1470 x 1137 pixels: 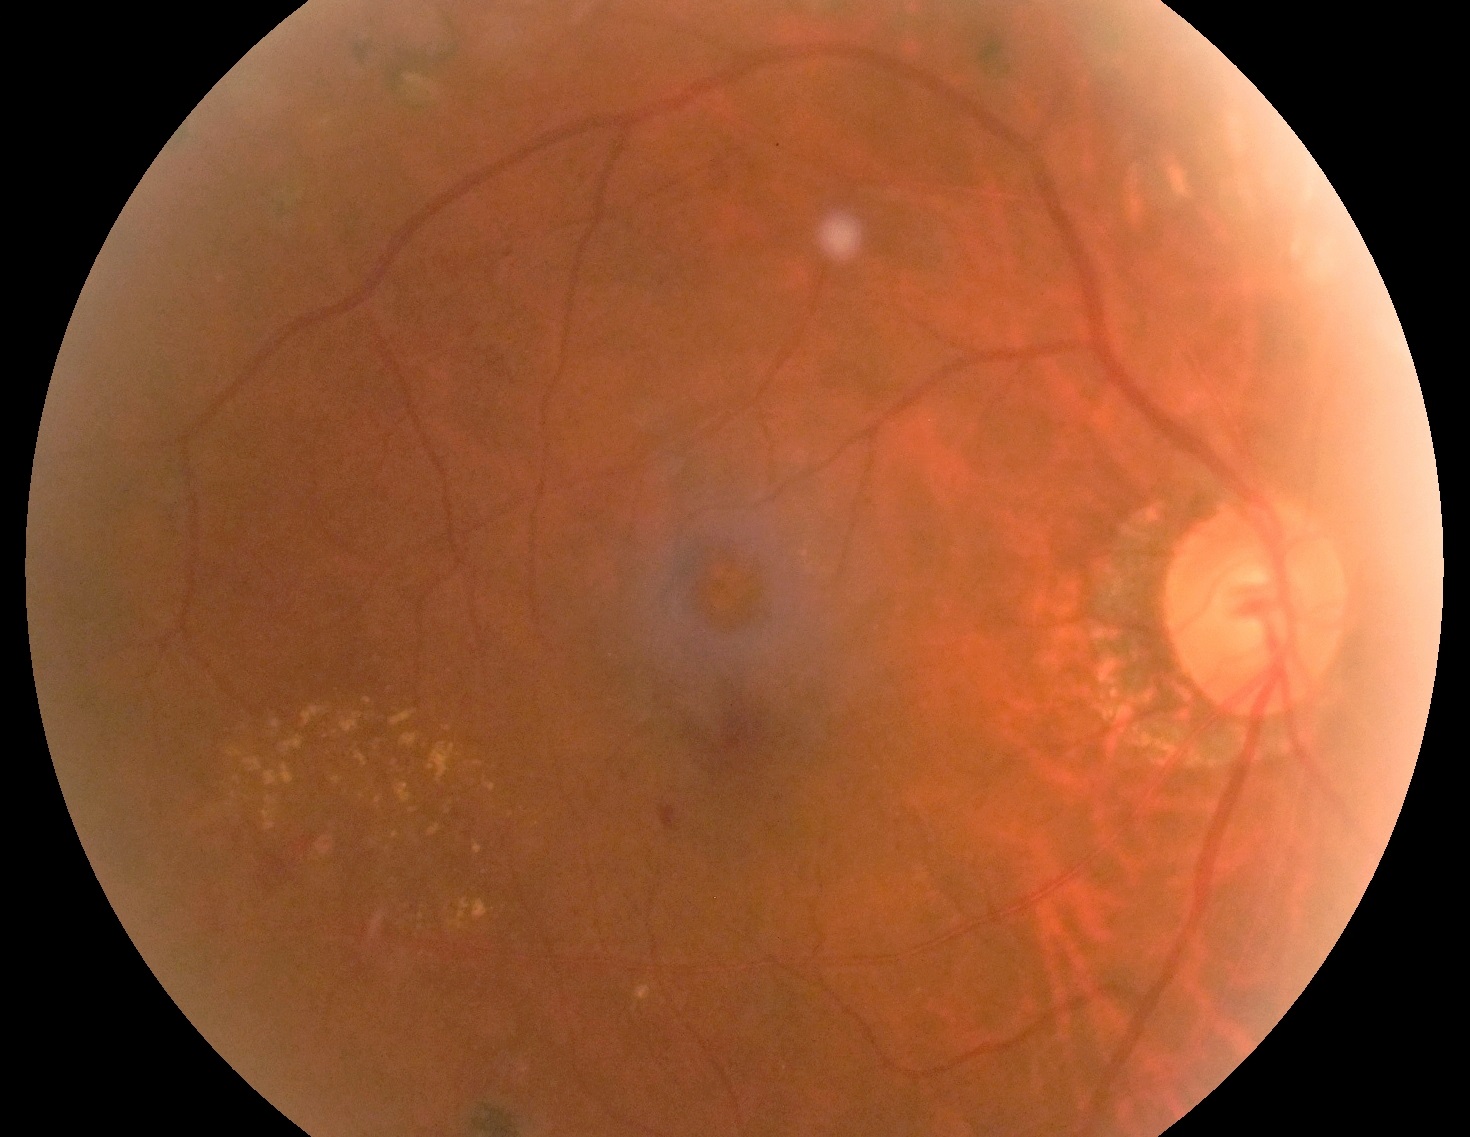

Diabetic retinopathy (DR) is 2.